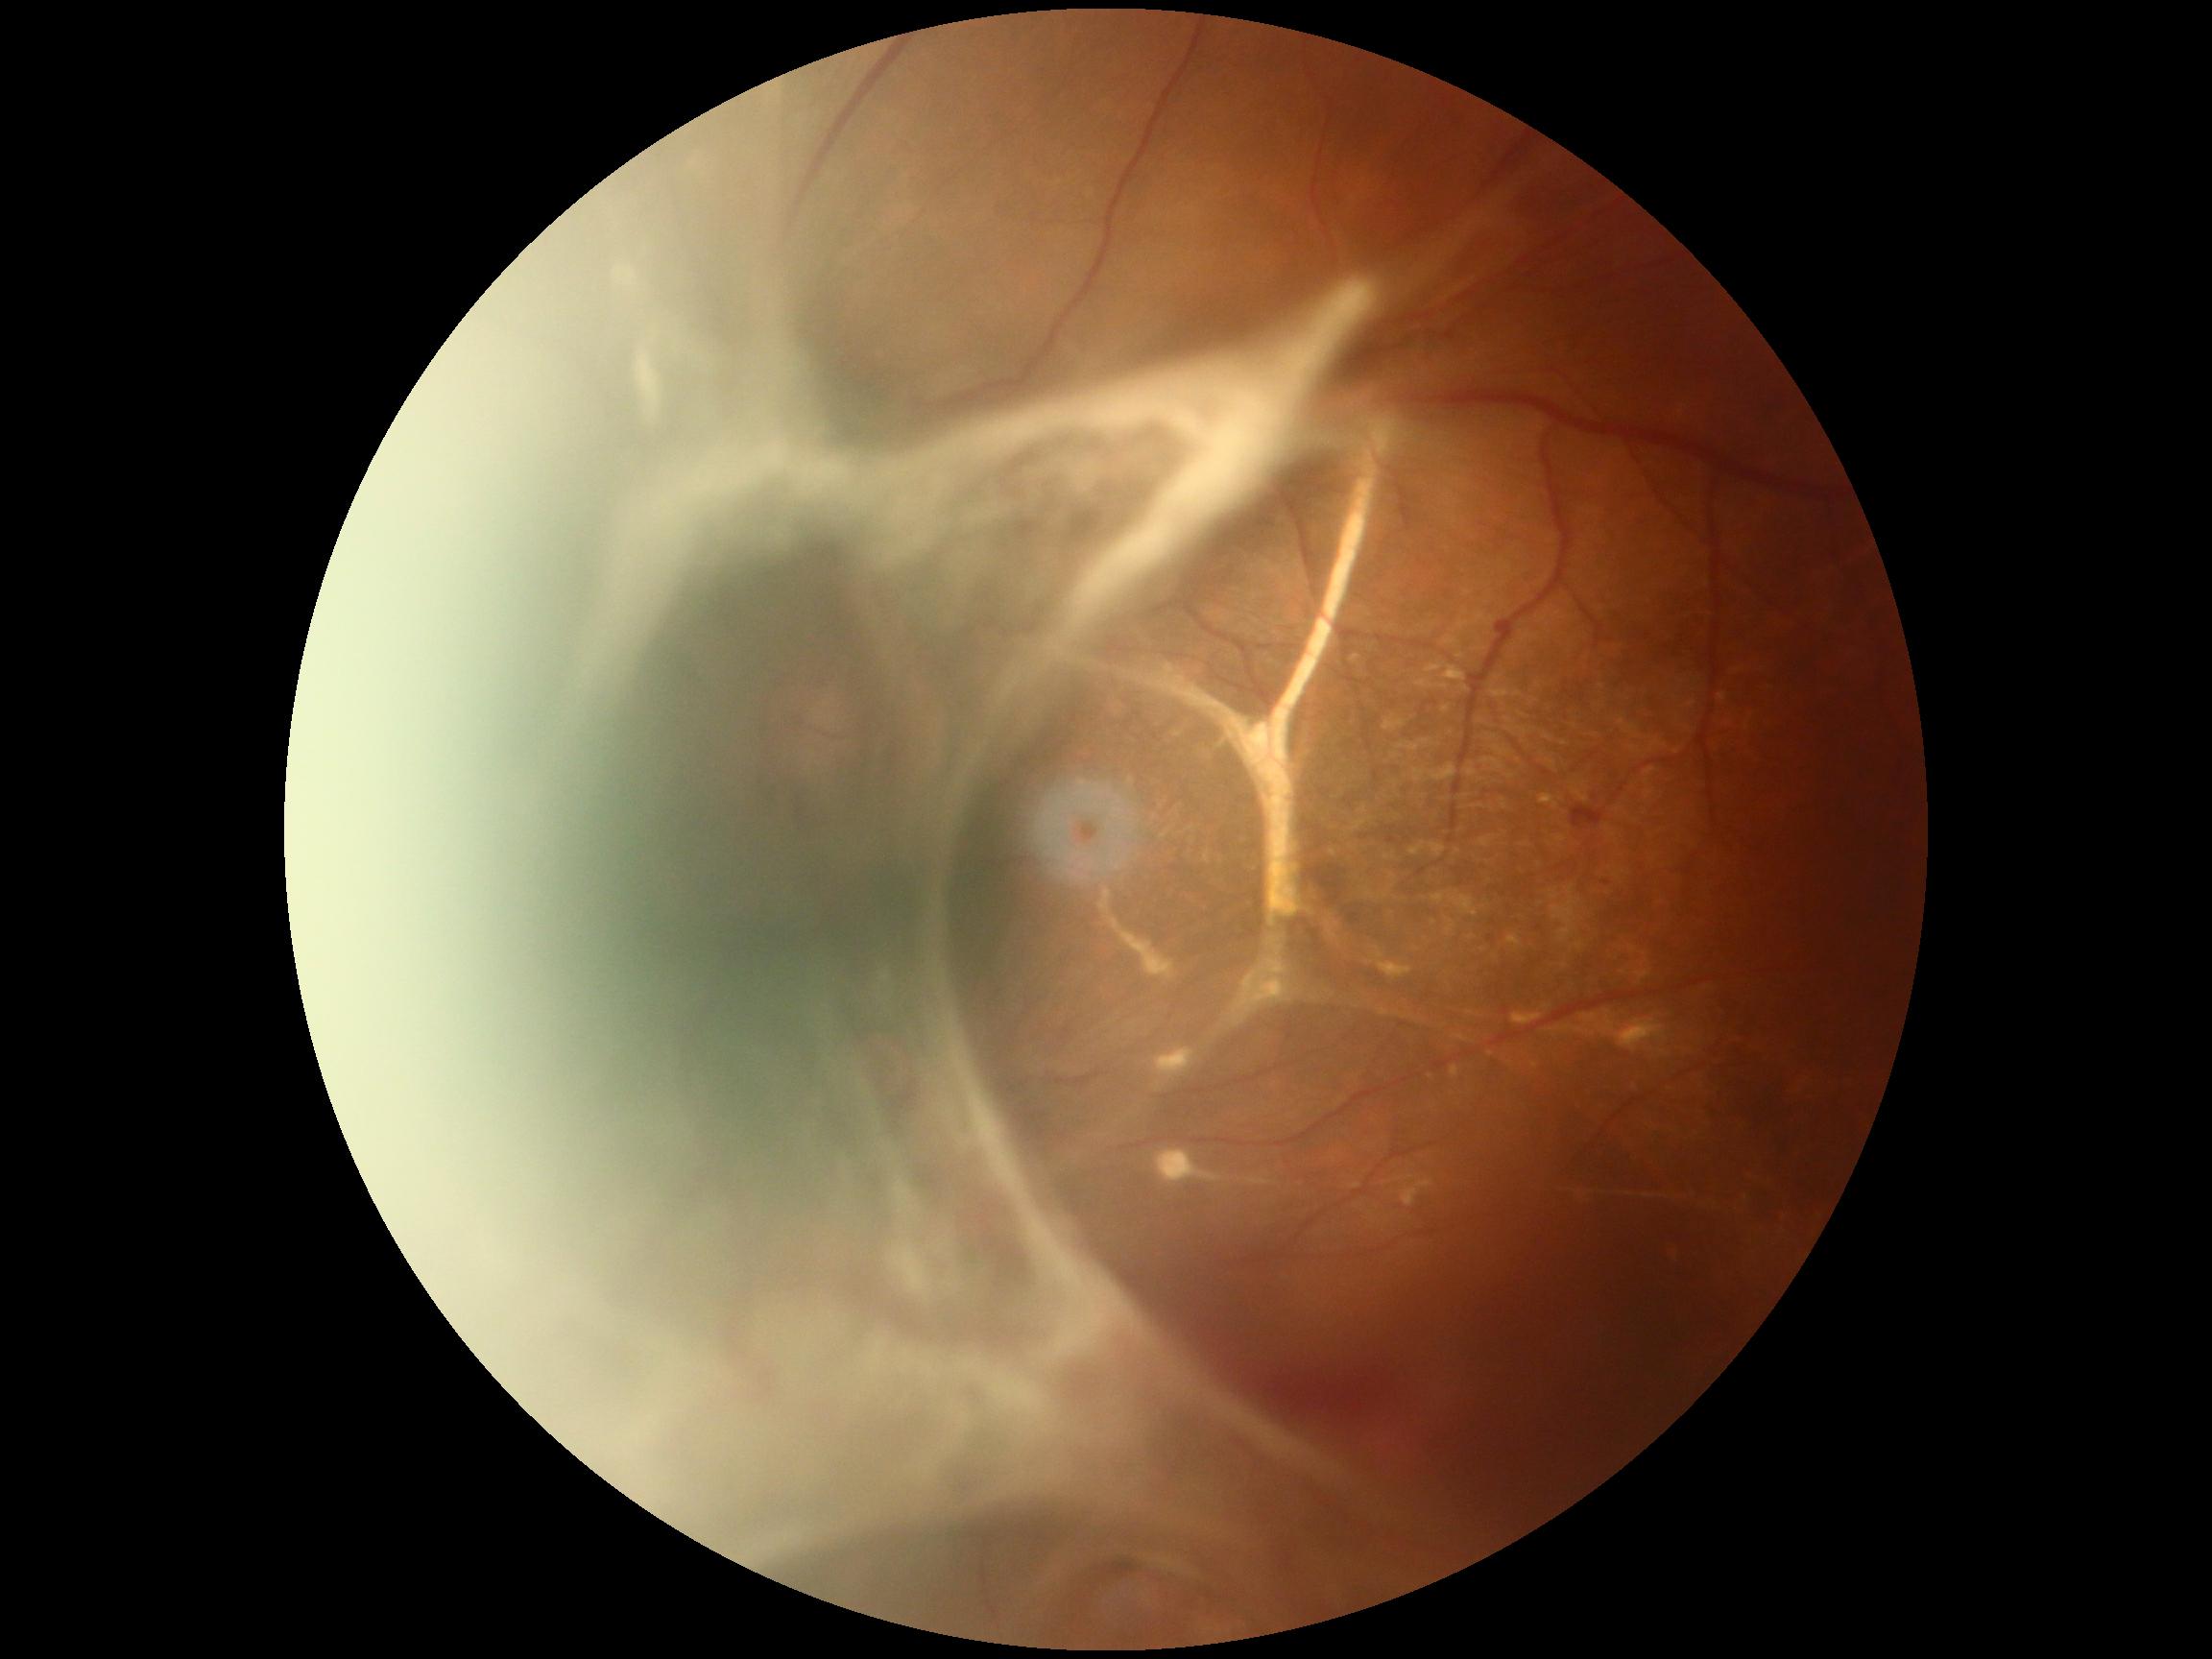
{"dr_grade": "grade 4 (PDR)"}